NIDEK AFC-230: 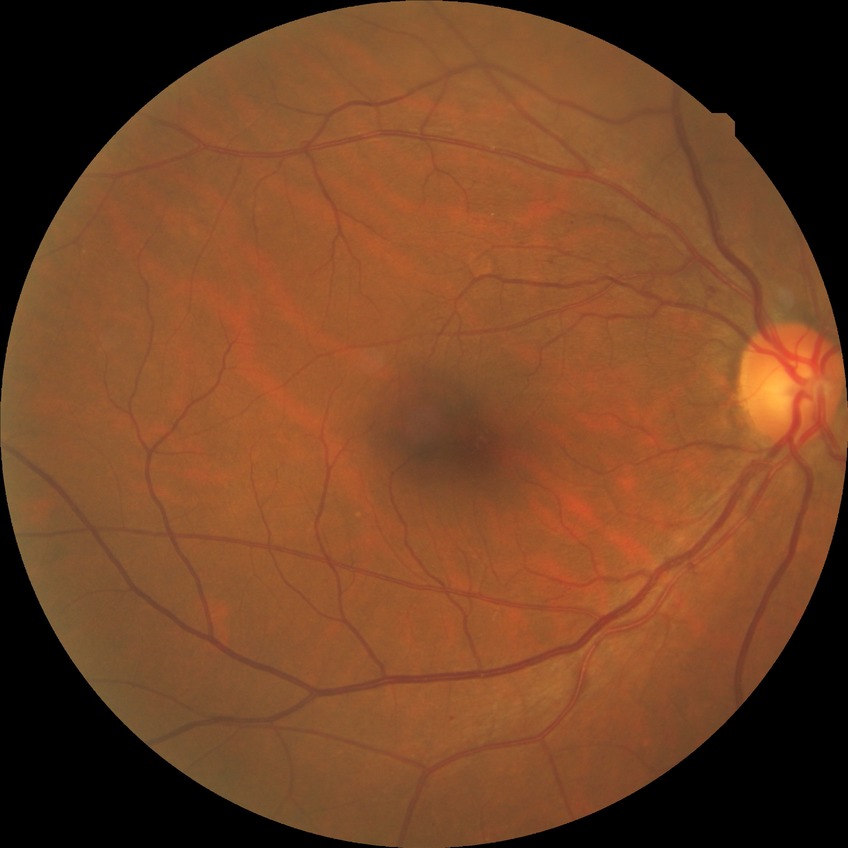 DR grade: NDR.